Acquired with a Remidio FOP fundus camera
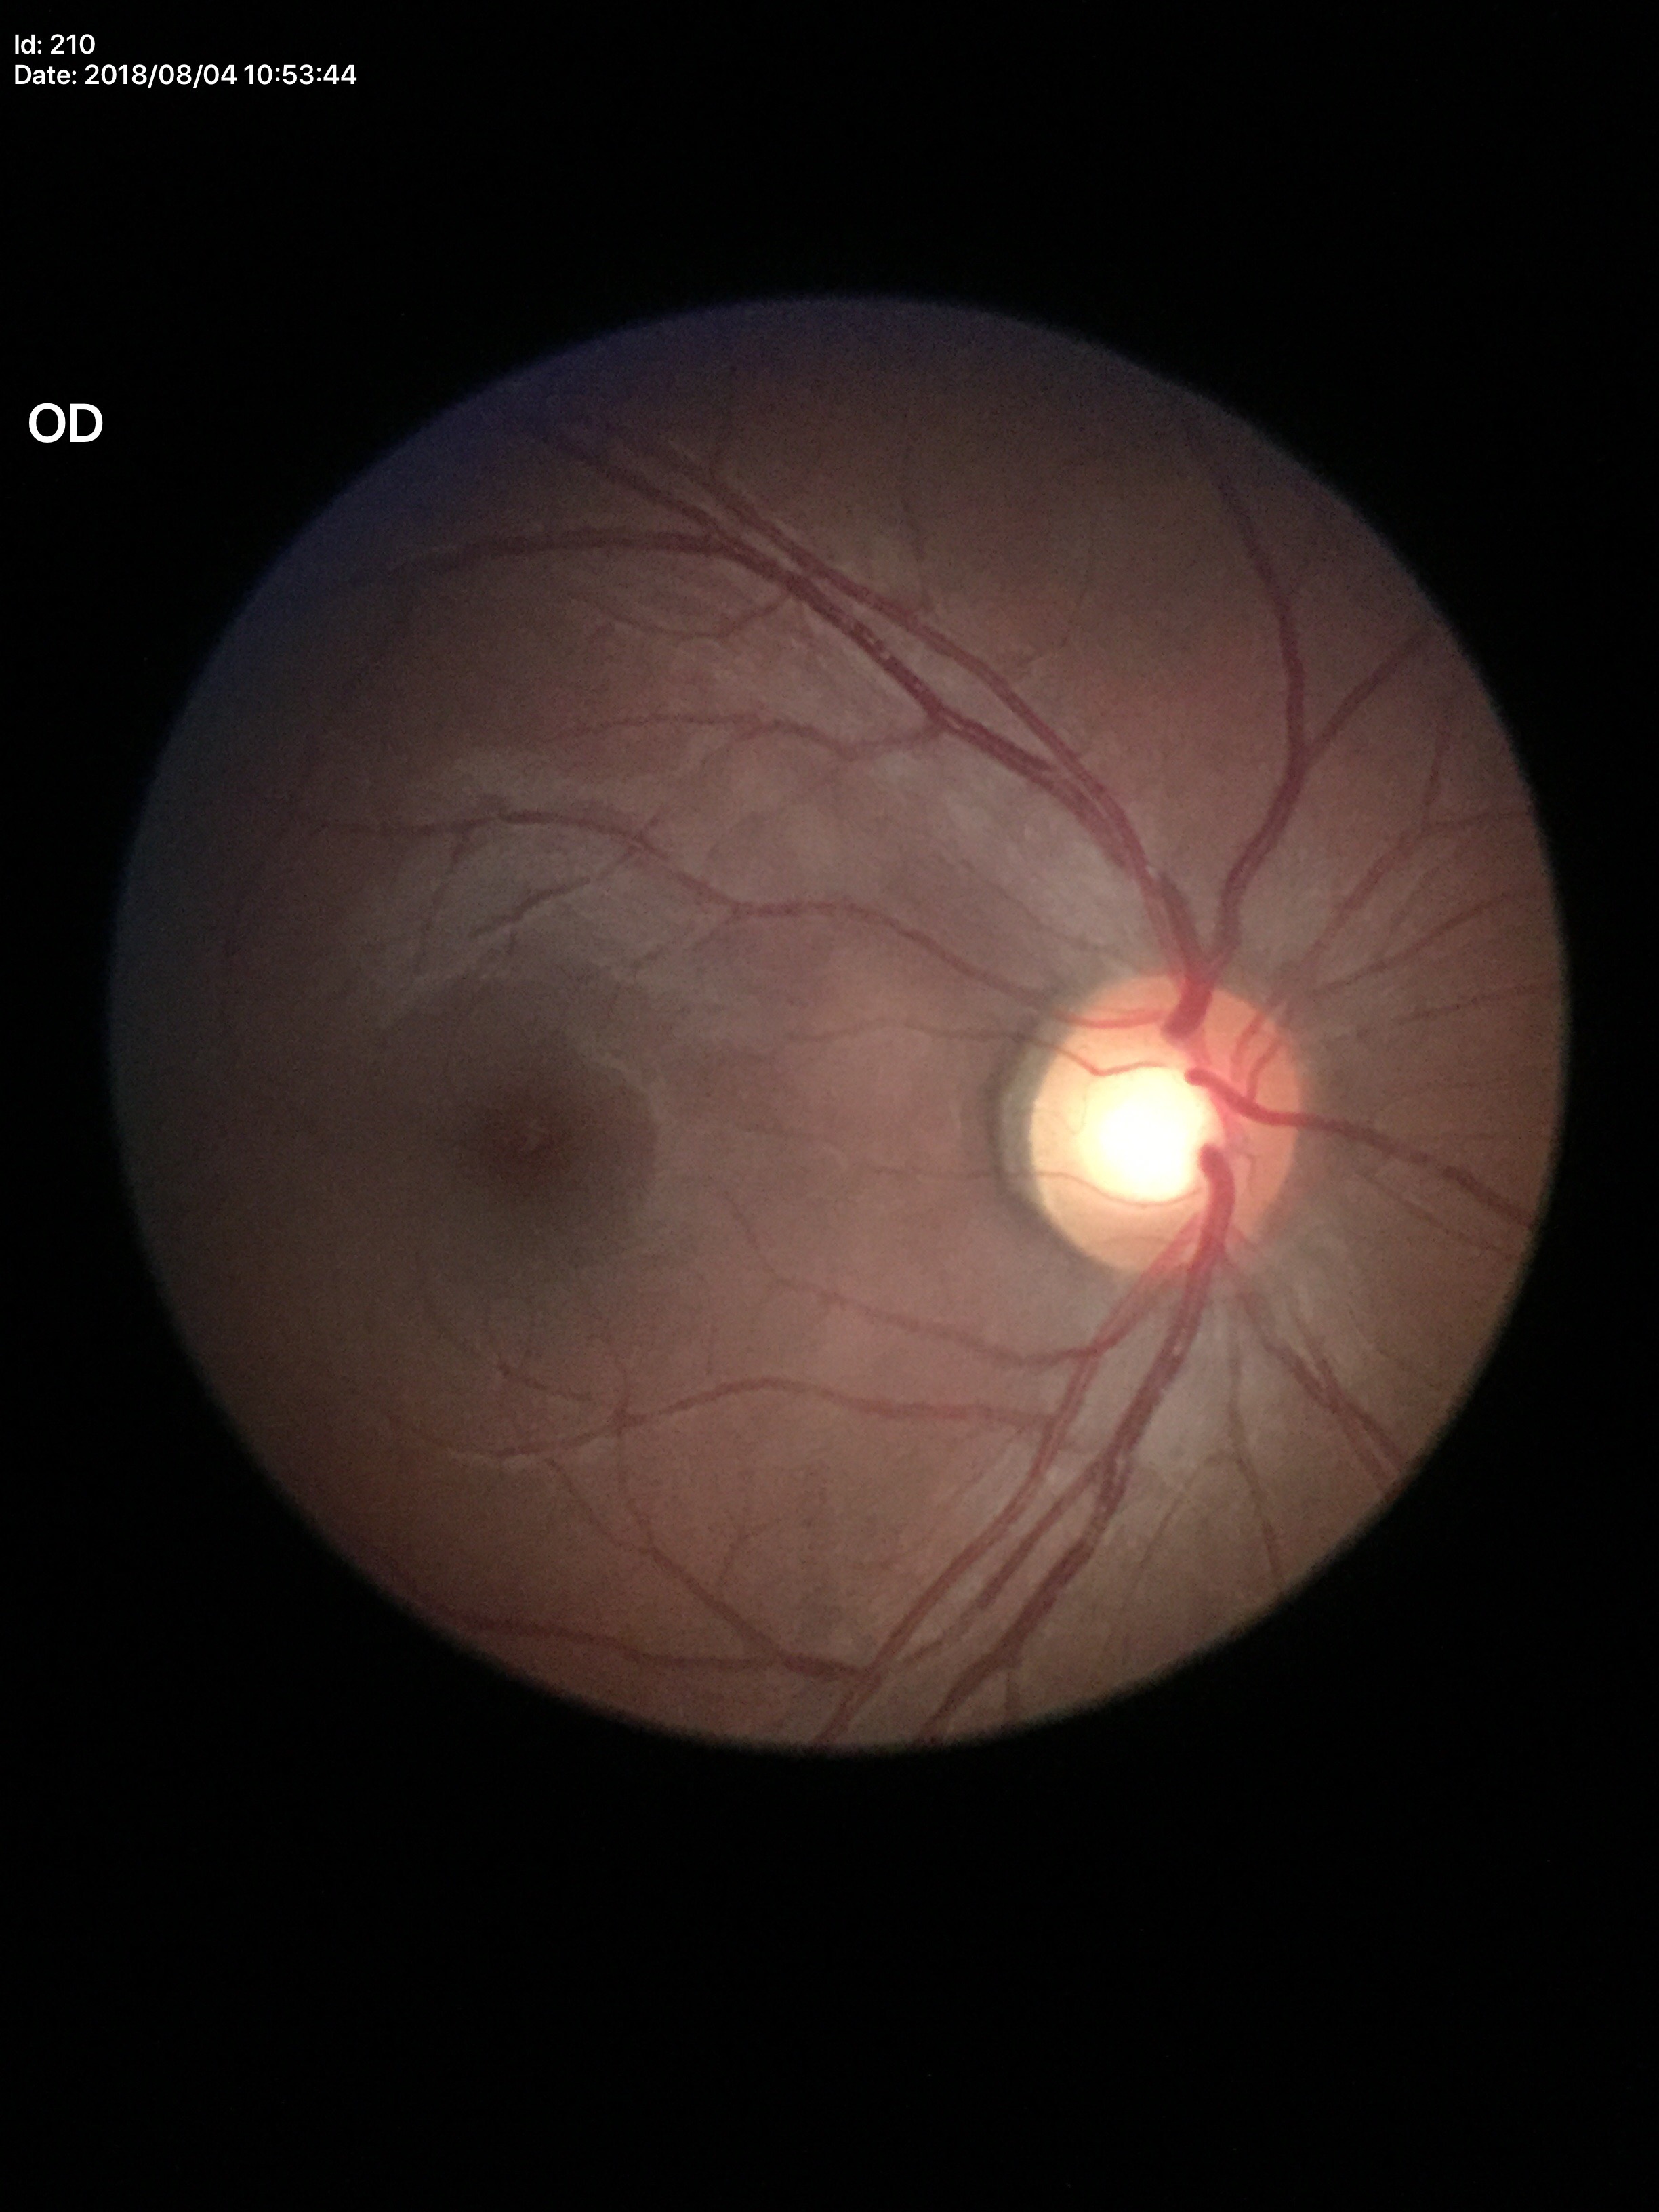

Negative for glaucoma suspicion (unanimous normal call).
Vertical C/D ratio (VCDR): 0.54.
Horizontal cup-disc ratio (HCDR) is 0.59.